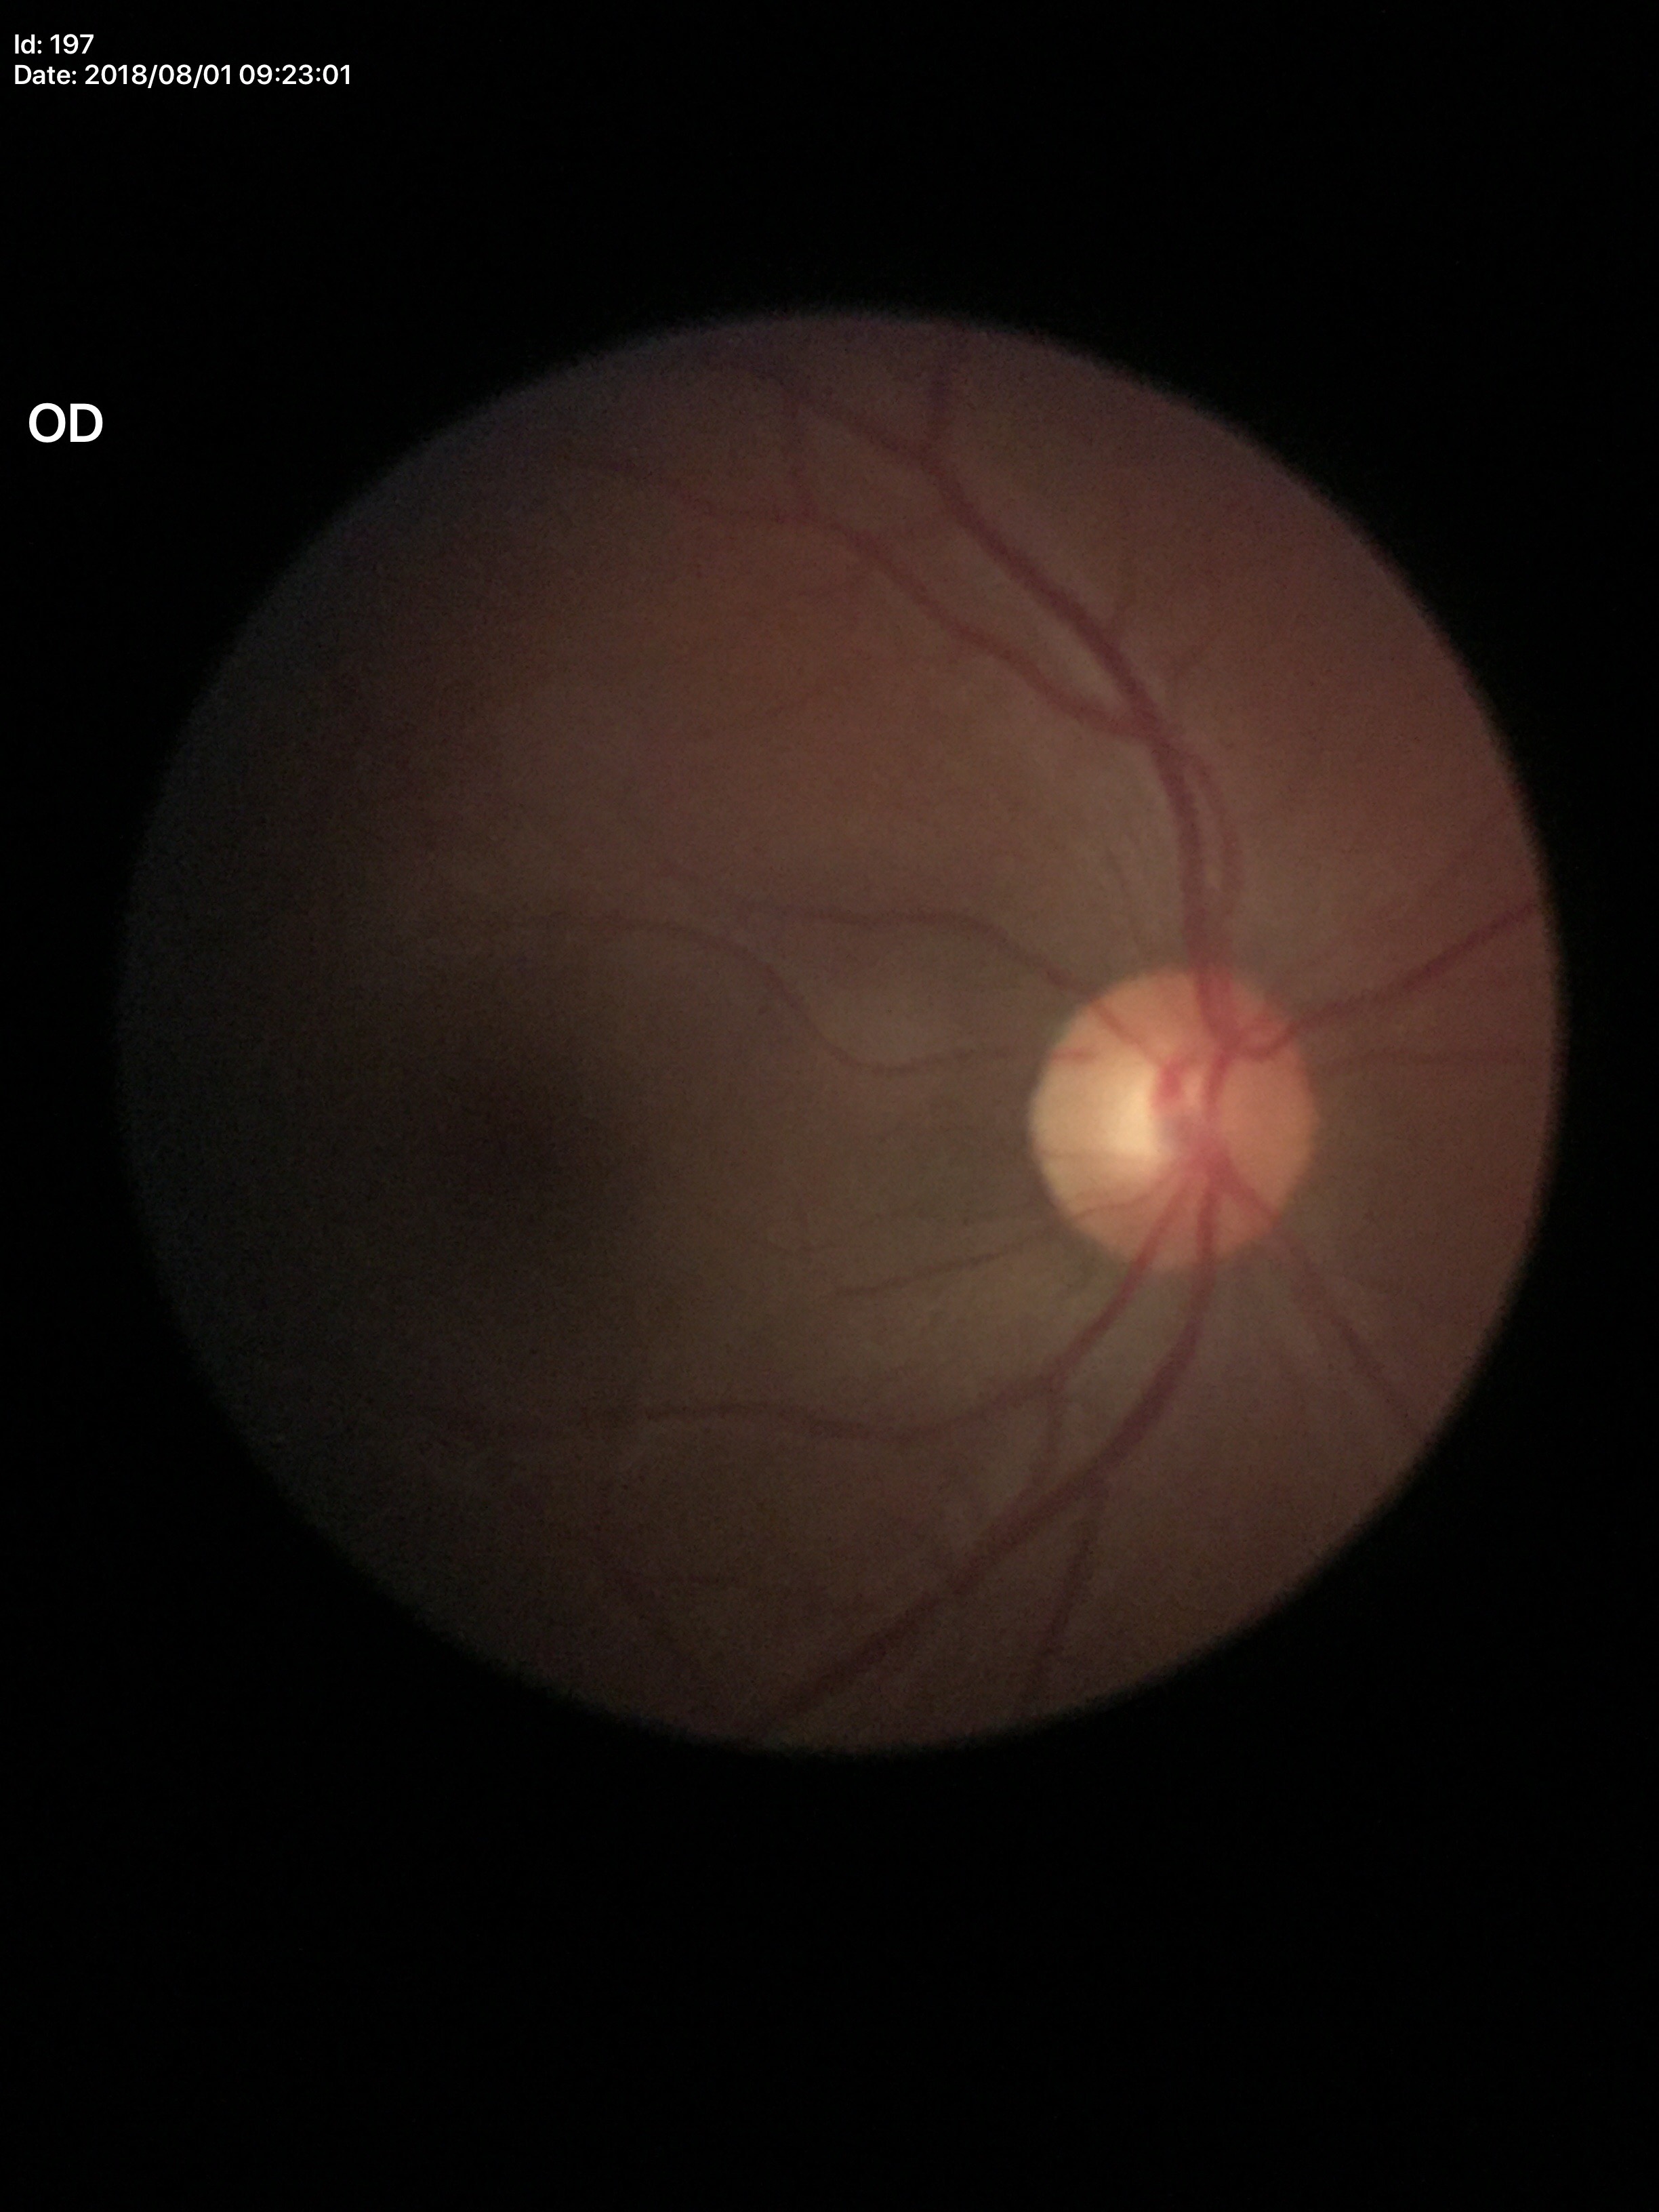
Glaucoma assessment: no suspicious findings, vertical cup-to-disc ratio: 0.51.